Pediatric wide-field fundus photograph. 1440x1080px.
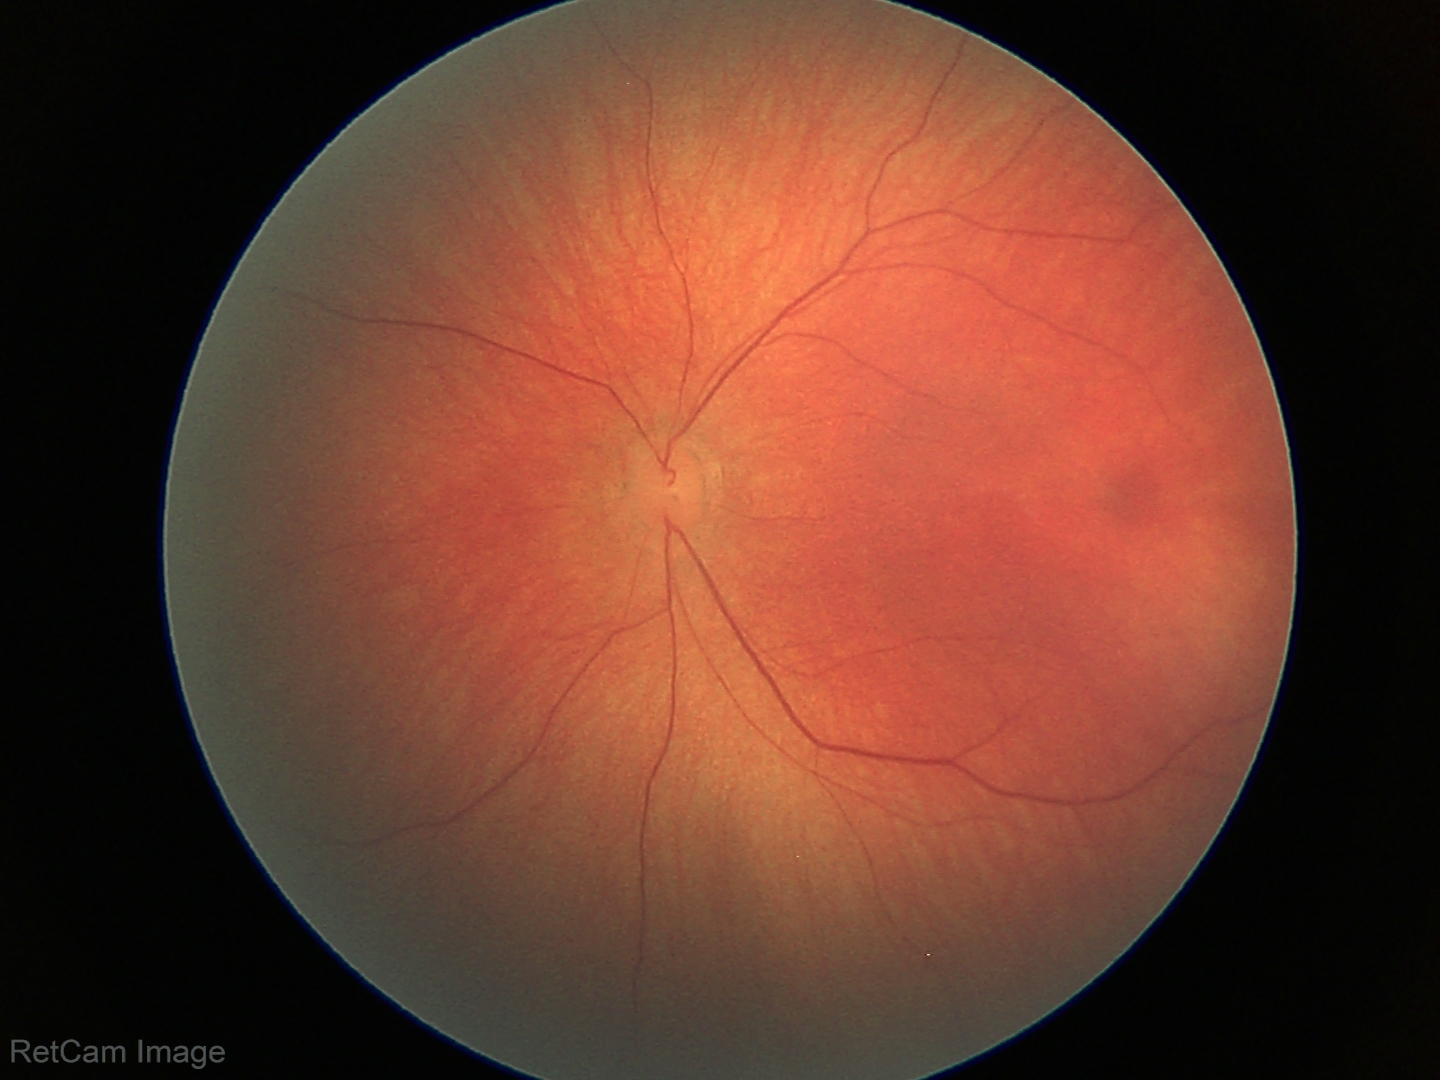
Screening diagnosis: normal fundus examination.